Color fundus image.
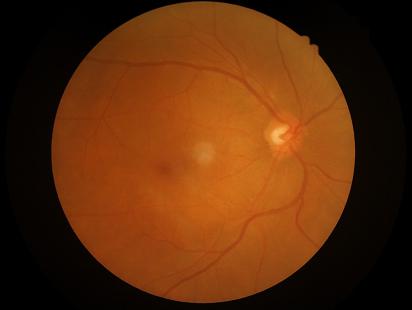
Good dynamic range. Illumination is even. Optic disc, vessels, and background are in focus. Overall quality is good and the image is gradable.